Optic nerve head photograph
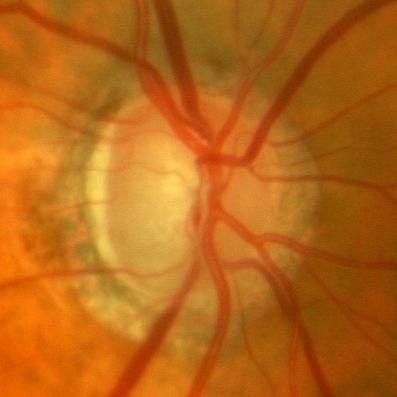
Demonstrates no glaucomatous changes.